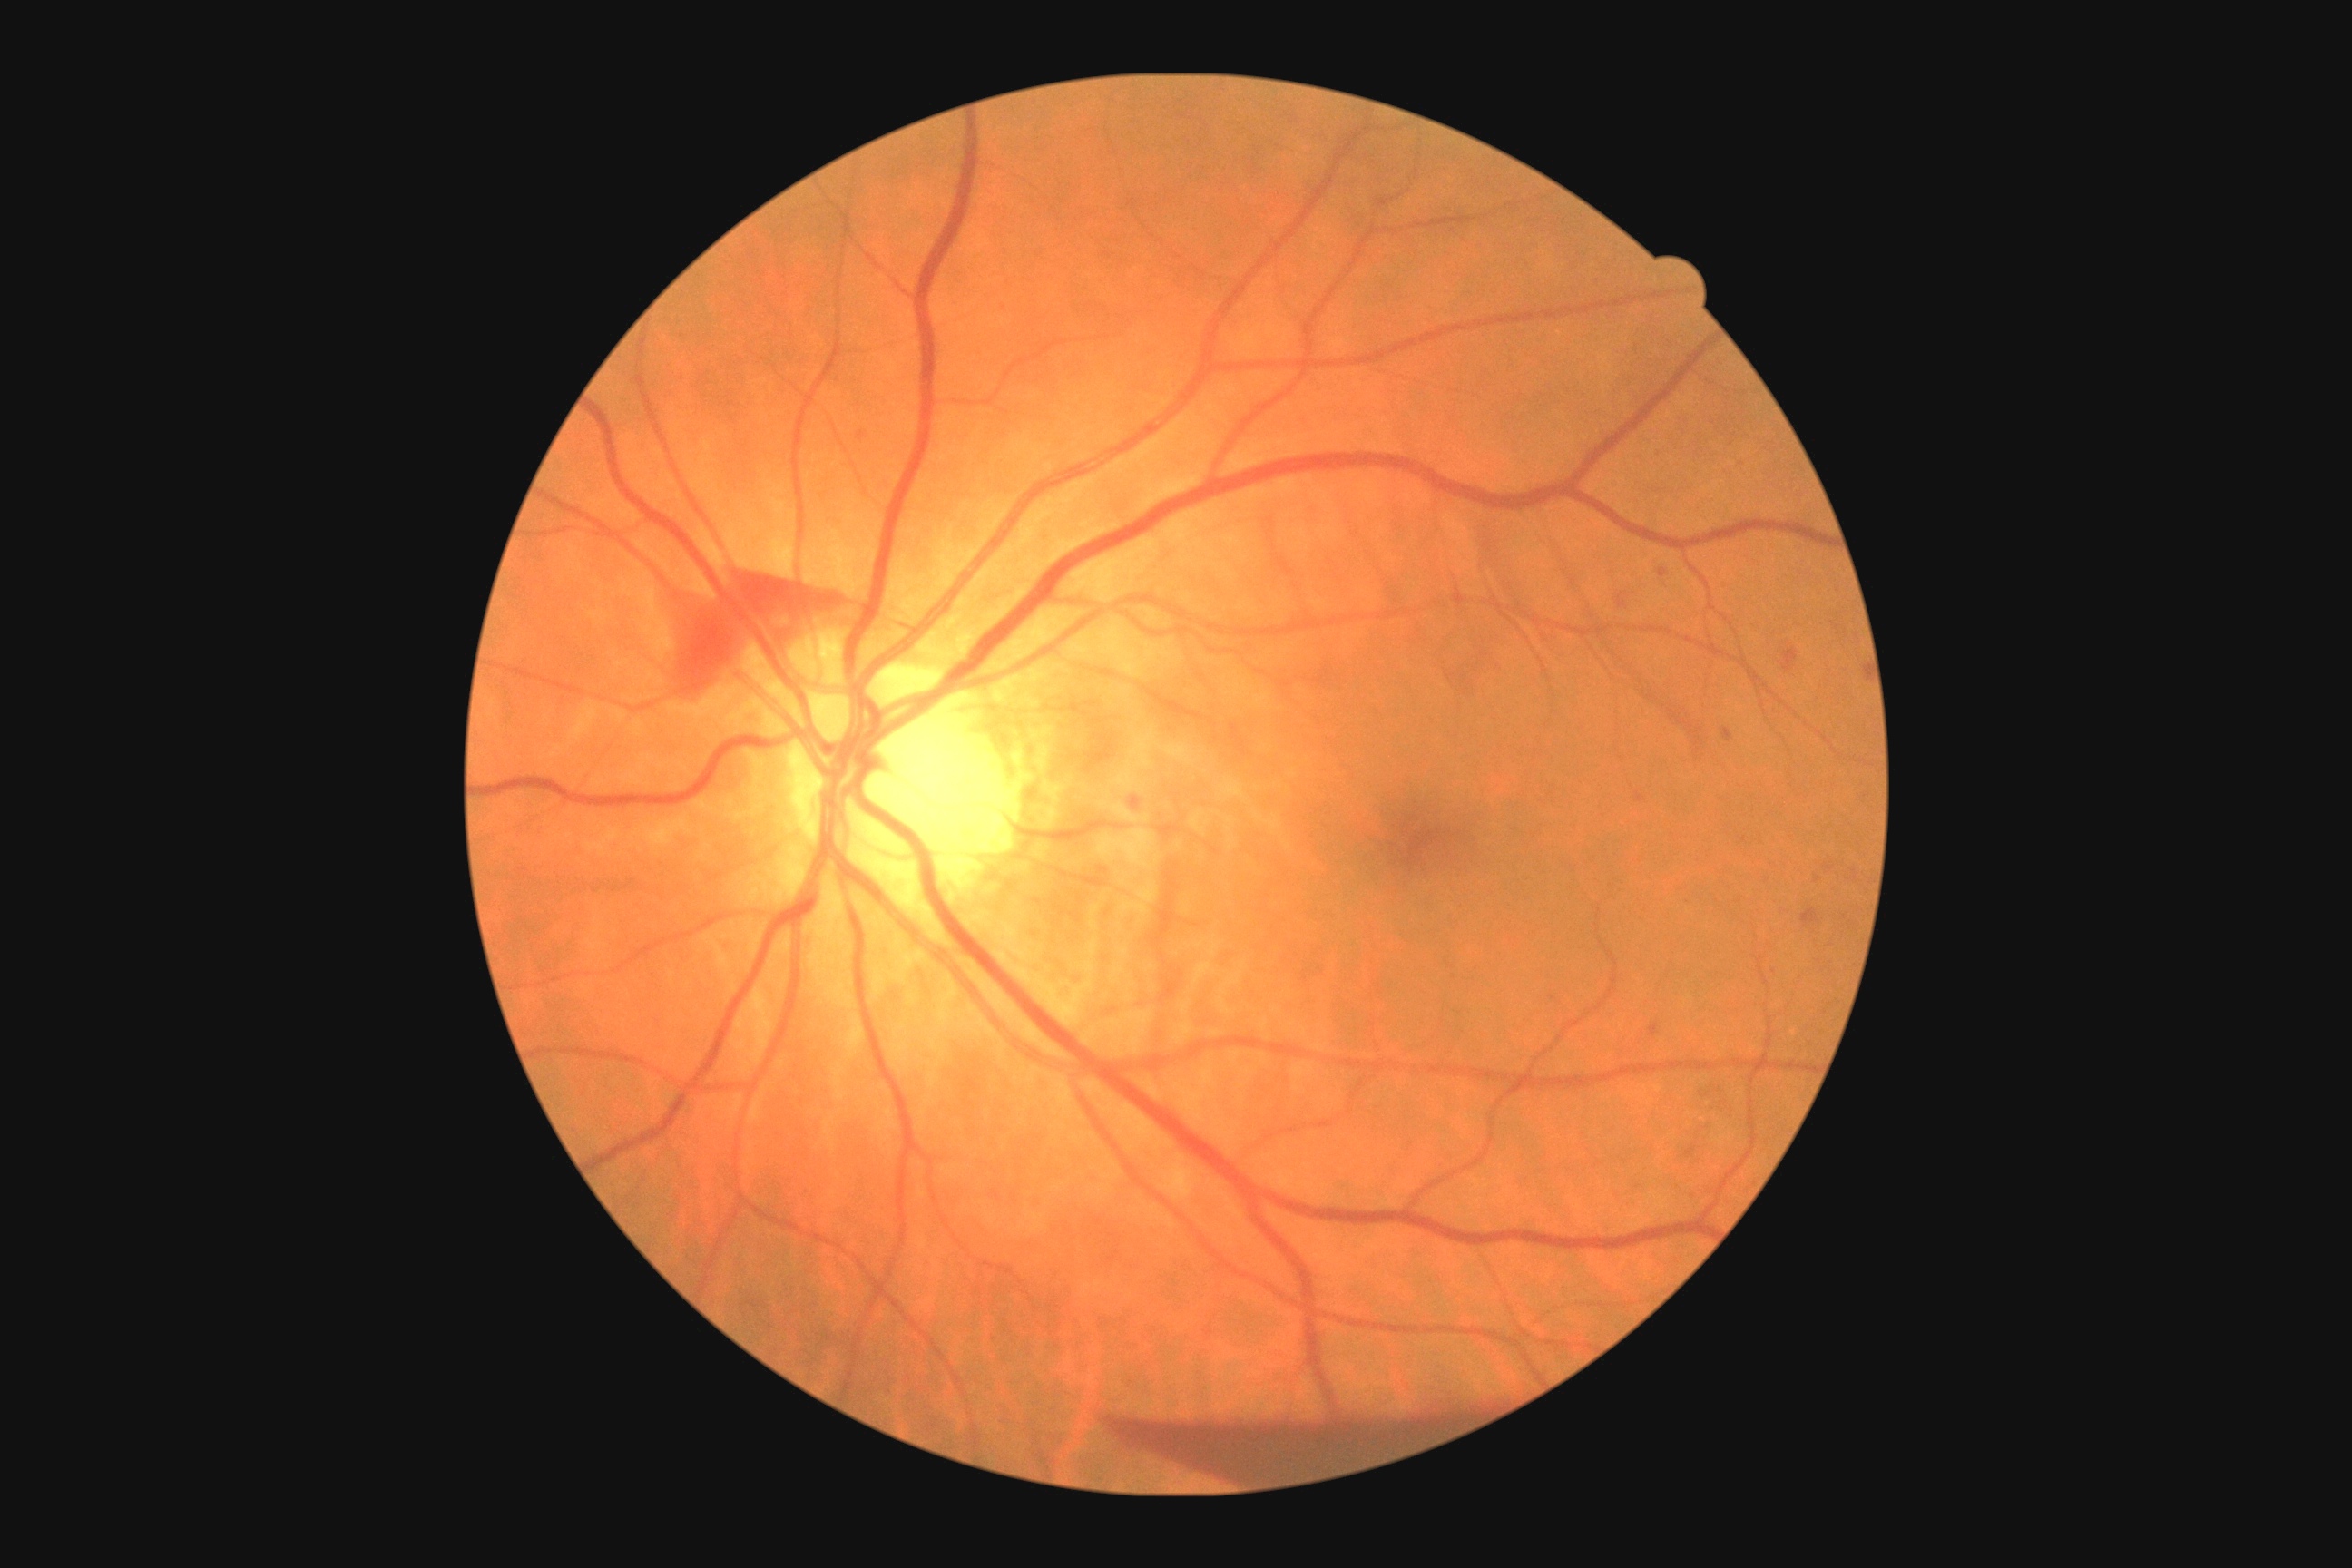

DR grade: 4 (PDR) — neovascularization and/or vitreous/pre-retinal hemorrhage
A subset of detected lesions:
* EXs: not present
* HEs (more not shown): (1478,531,1556,651) | (1455,591,1502,667) | (1783,649,1799,672) | (1446,634,1462,652) | (1616,593,1627,609) | (1801,908,1819,928) | (1449,654,1489,696) | (1113,1418,1465,1480) | (1700,1088,1729,1112) | (1542,514,1710,760) | (1130,796,1144,810) | (1685,1146,1696,1159) | (671,573,841,687)
* Small HEs near x=1438 y=659 | x=1445 y=668
* SEs: not present
* MAs: (1660,569,1669,578) | (1636,792,1645,803) | (1649,1023,1660,1035) | (1101,868,1108,876) | (1825,865,1834,872) | (1723,729,1732,741)
* Small MAs near x=1774 y=972 | x=1818 y=880 | x=1553 y=999